Cropped to the optic nerve head, Nidek AFC-330, non-mydriatic acquisition — 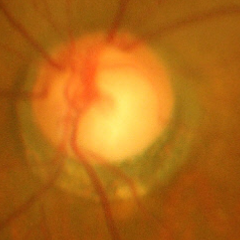

There is evidence of advanced glaucomatous optic neuropathy. (Criteria: near-total cupping of the optic nerve head, with or without severe visual field loss within the central 10 degrees of fixation.)